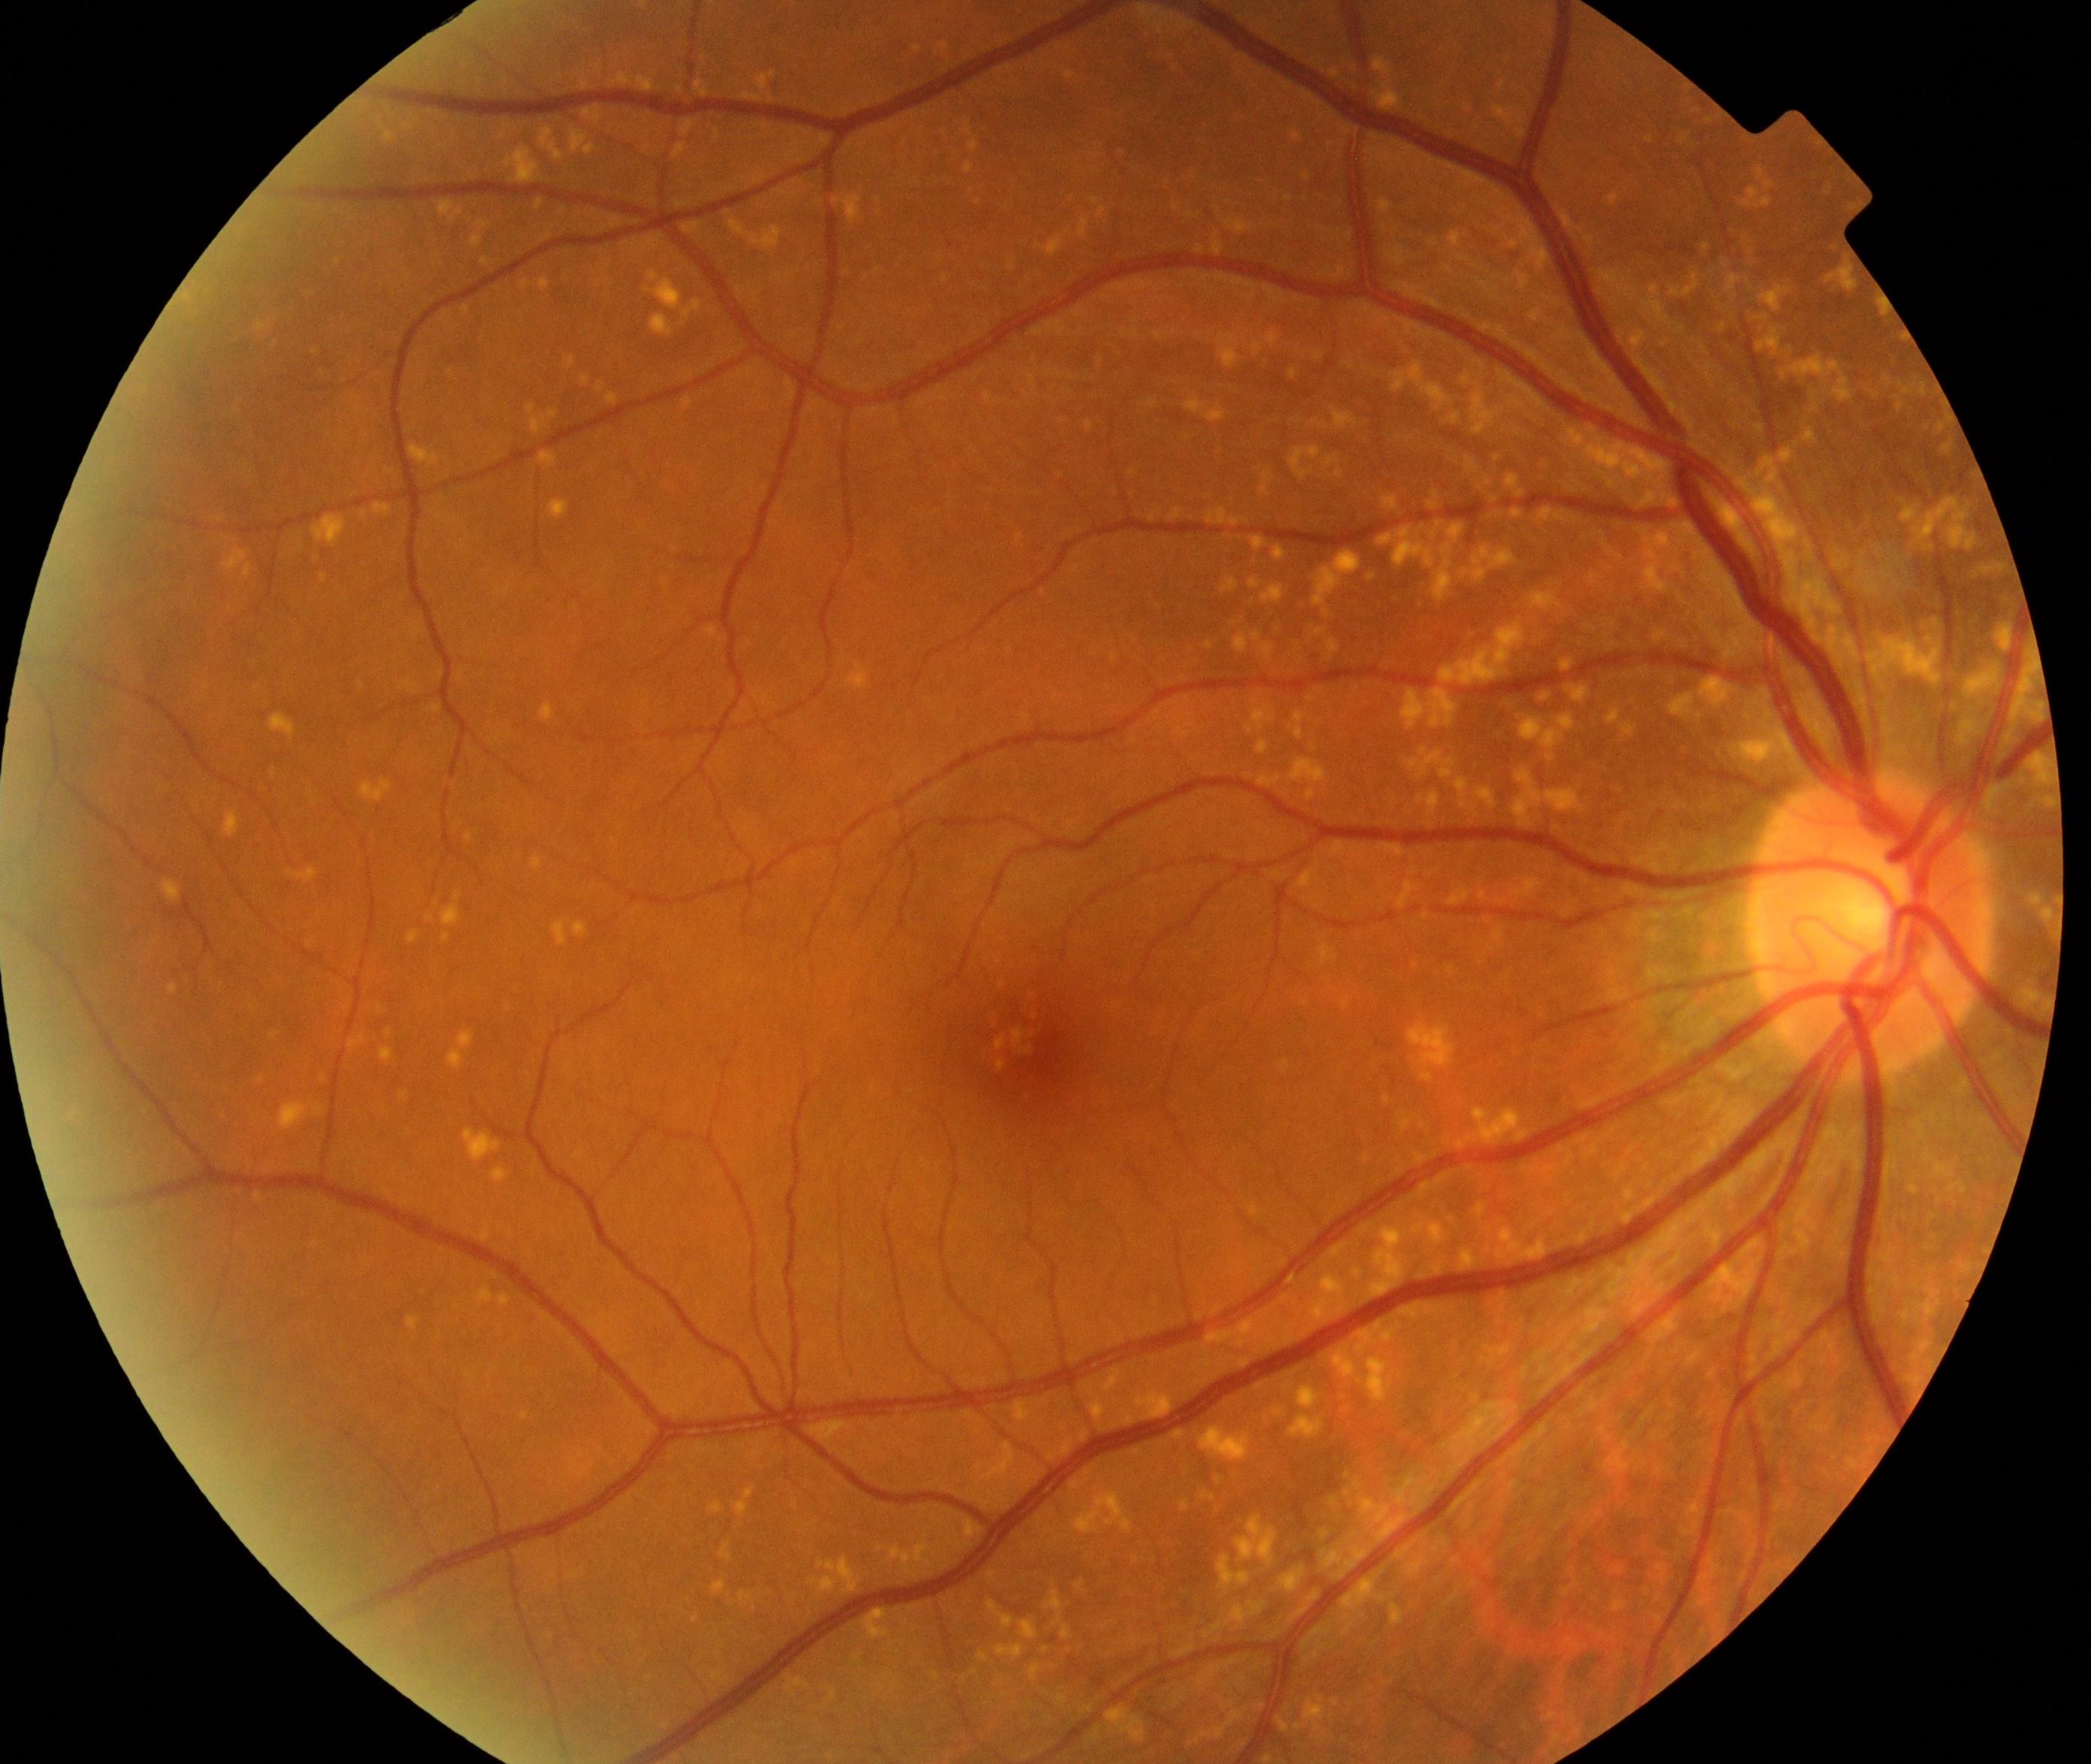 Appearance consistent with yellow-white spots or flecks.